Acquired on the Phoenix ICON. Wide-field fundus image from infant ROP screening
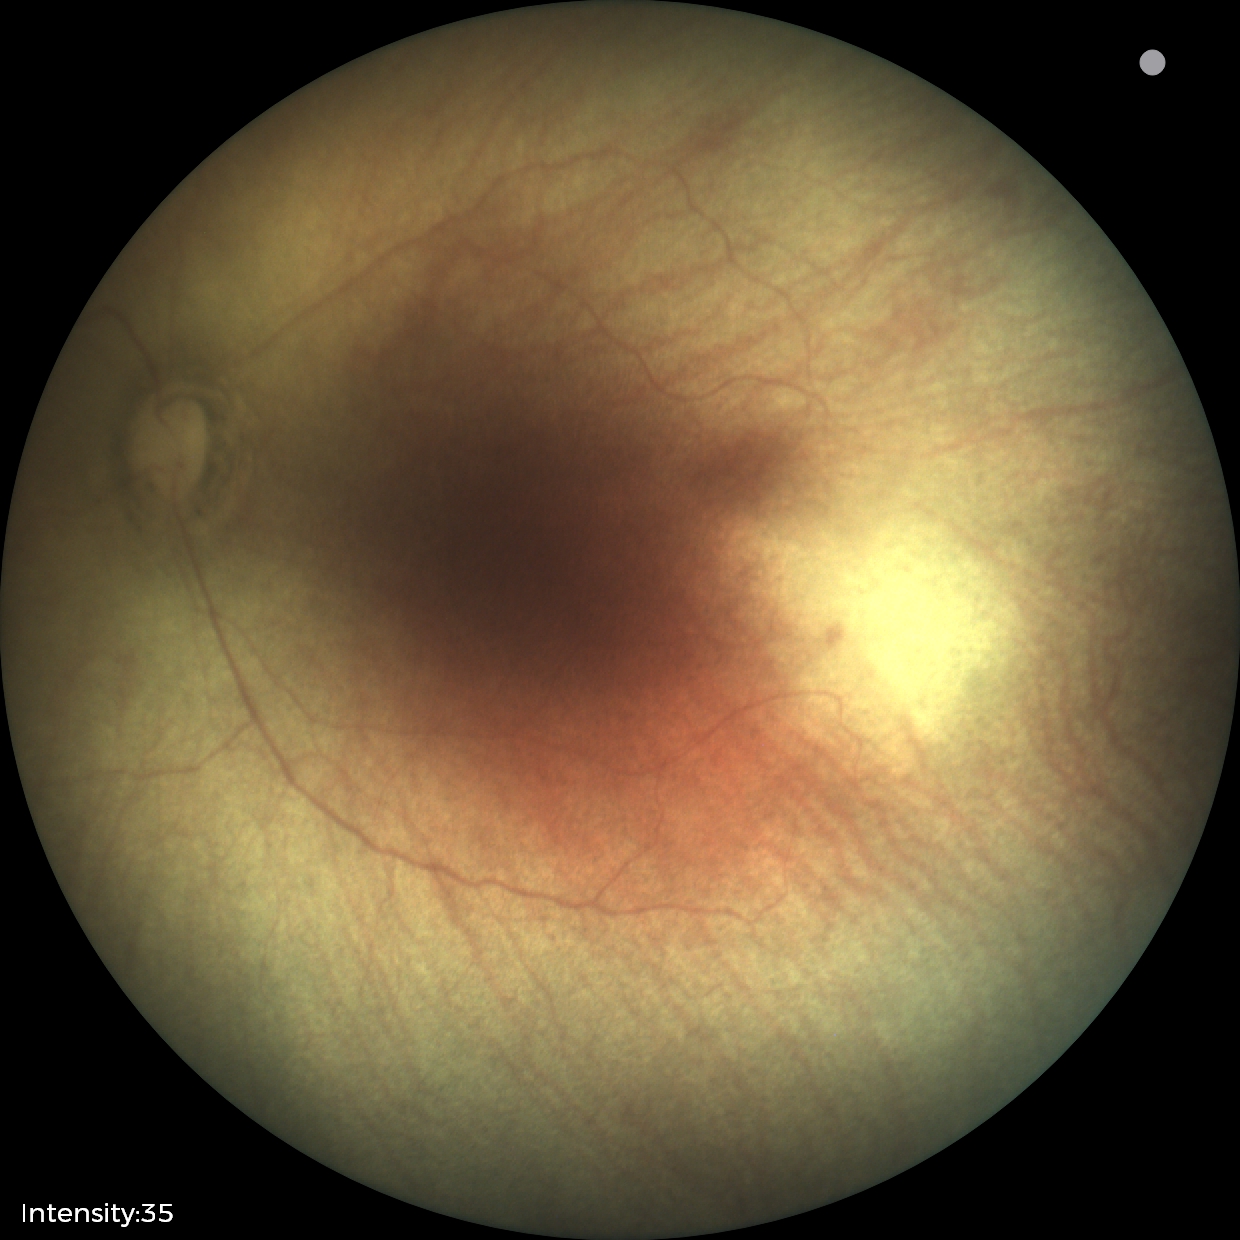

Diagnosis from this screening exam: ROP stage 0.